Color fundus photograph · graded on the modified Davis scale · NIDEK AFC-230
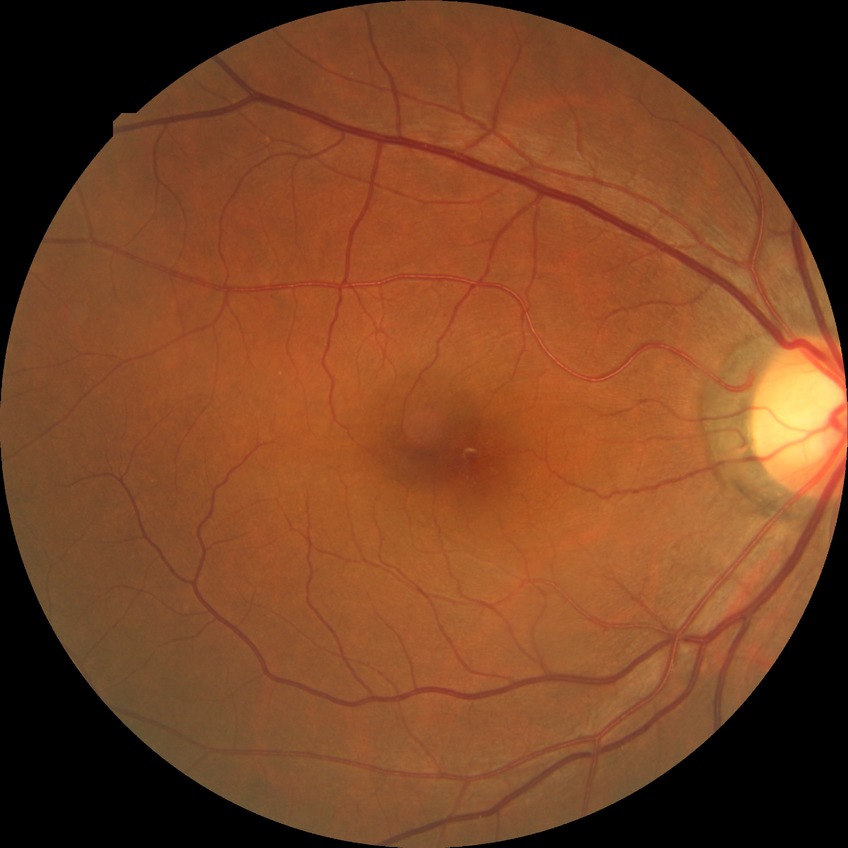

Diabetic retinopathy (DR): NDR (no diabetic retinopathy).